Nonmydriatic · graded on the modified Davis scale:
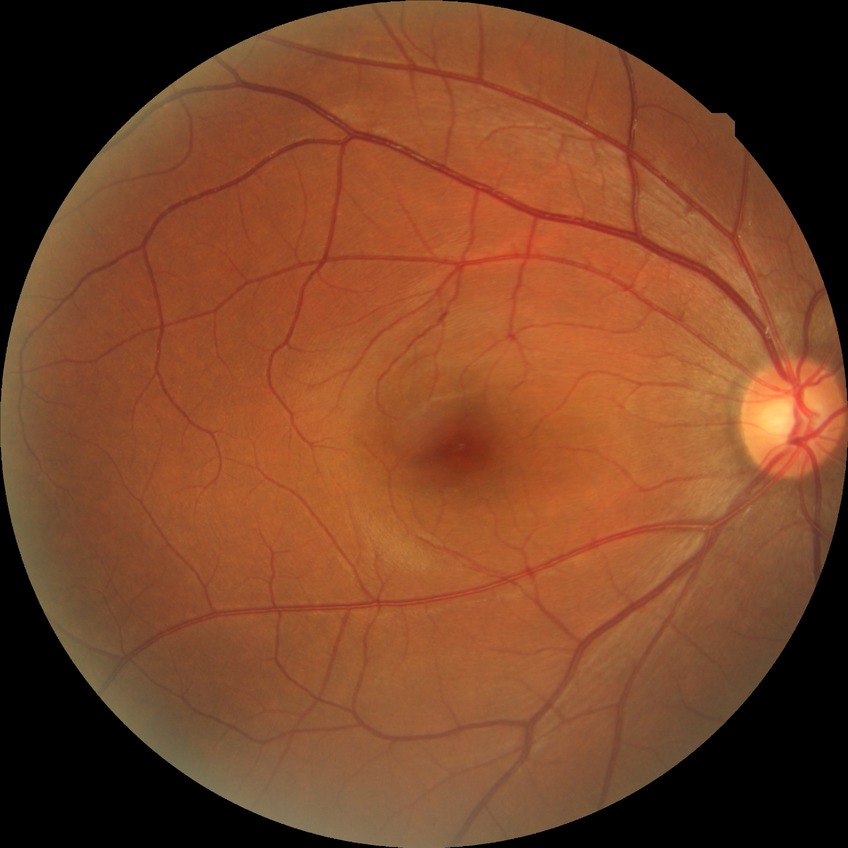
Diabetic retinopathy (DR): no diabetic retinopathy (NDR).